Davis DR grading. Fundus photo. 45° FOV: 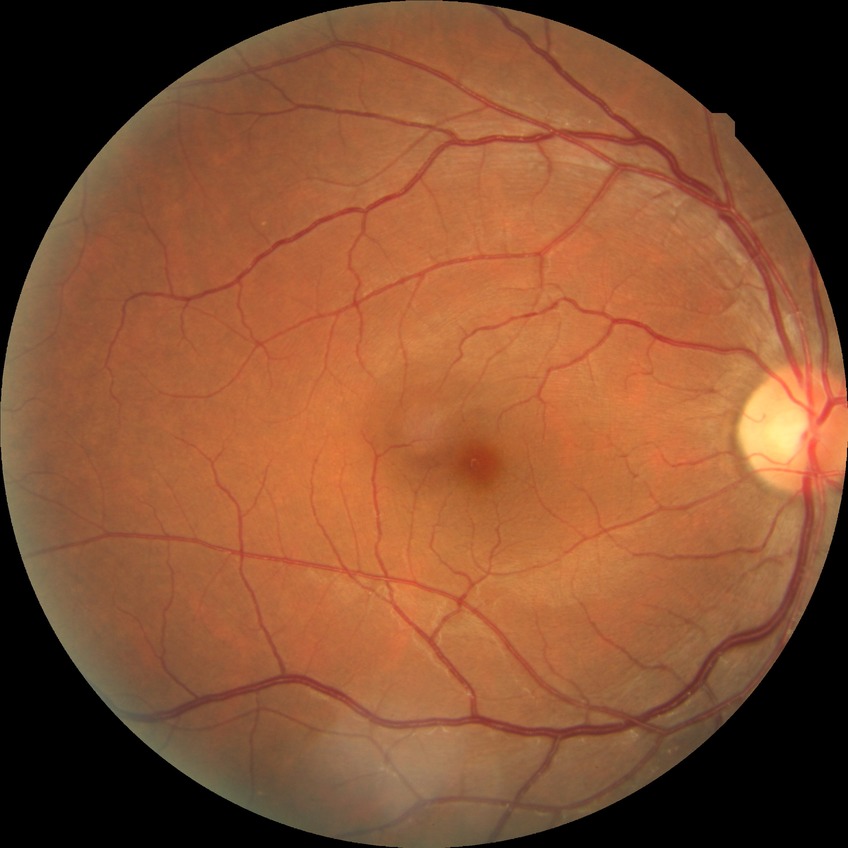
Diabetic retinopathy (DR): no diabetic retinopathy (NDR).